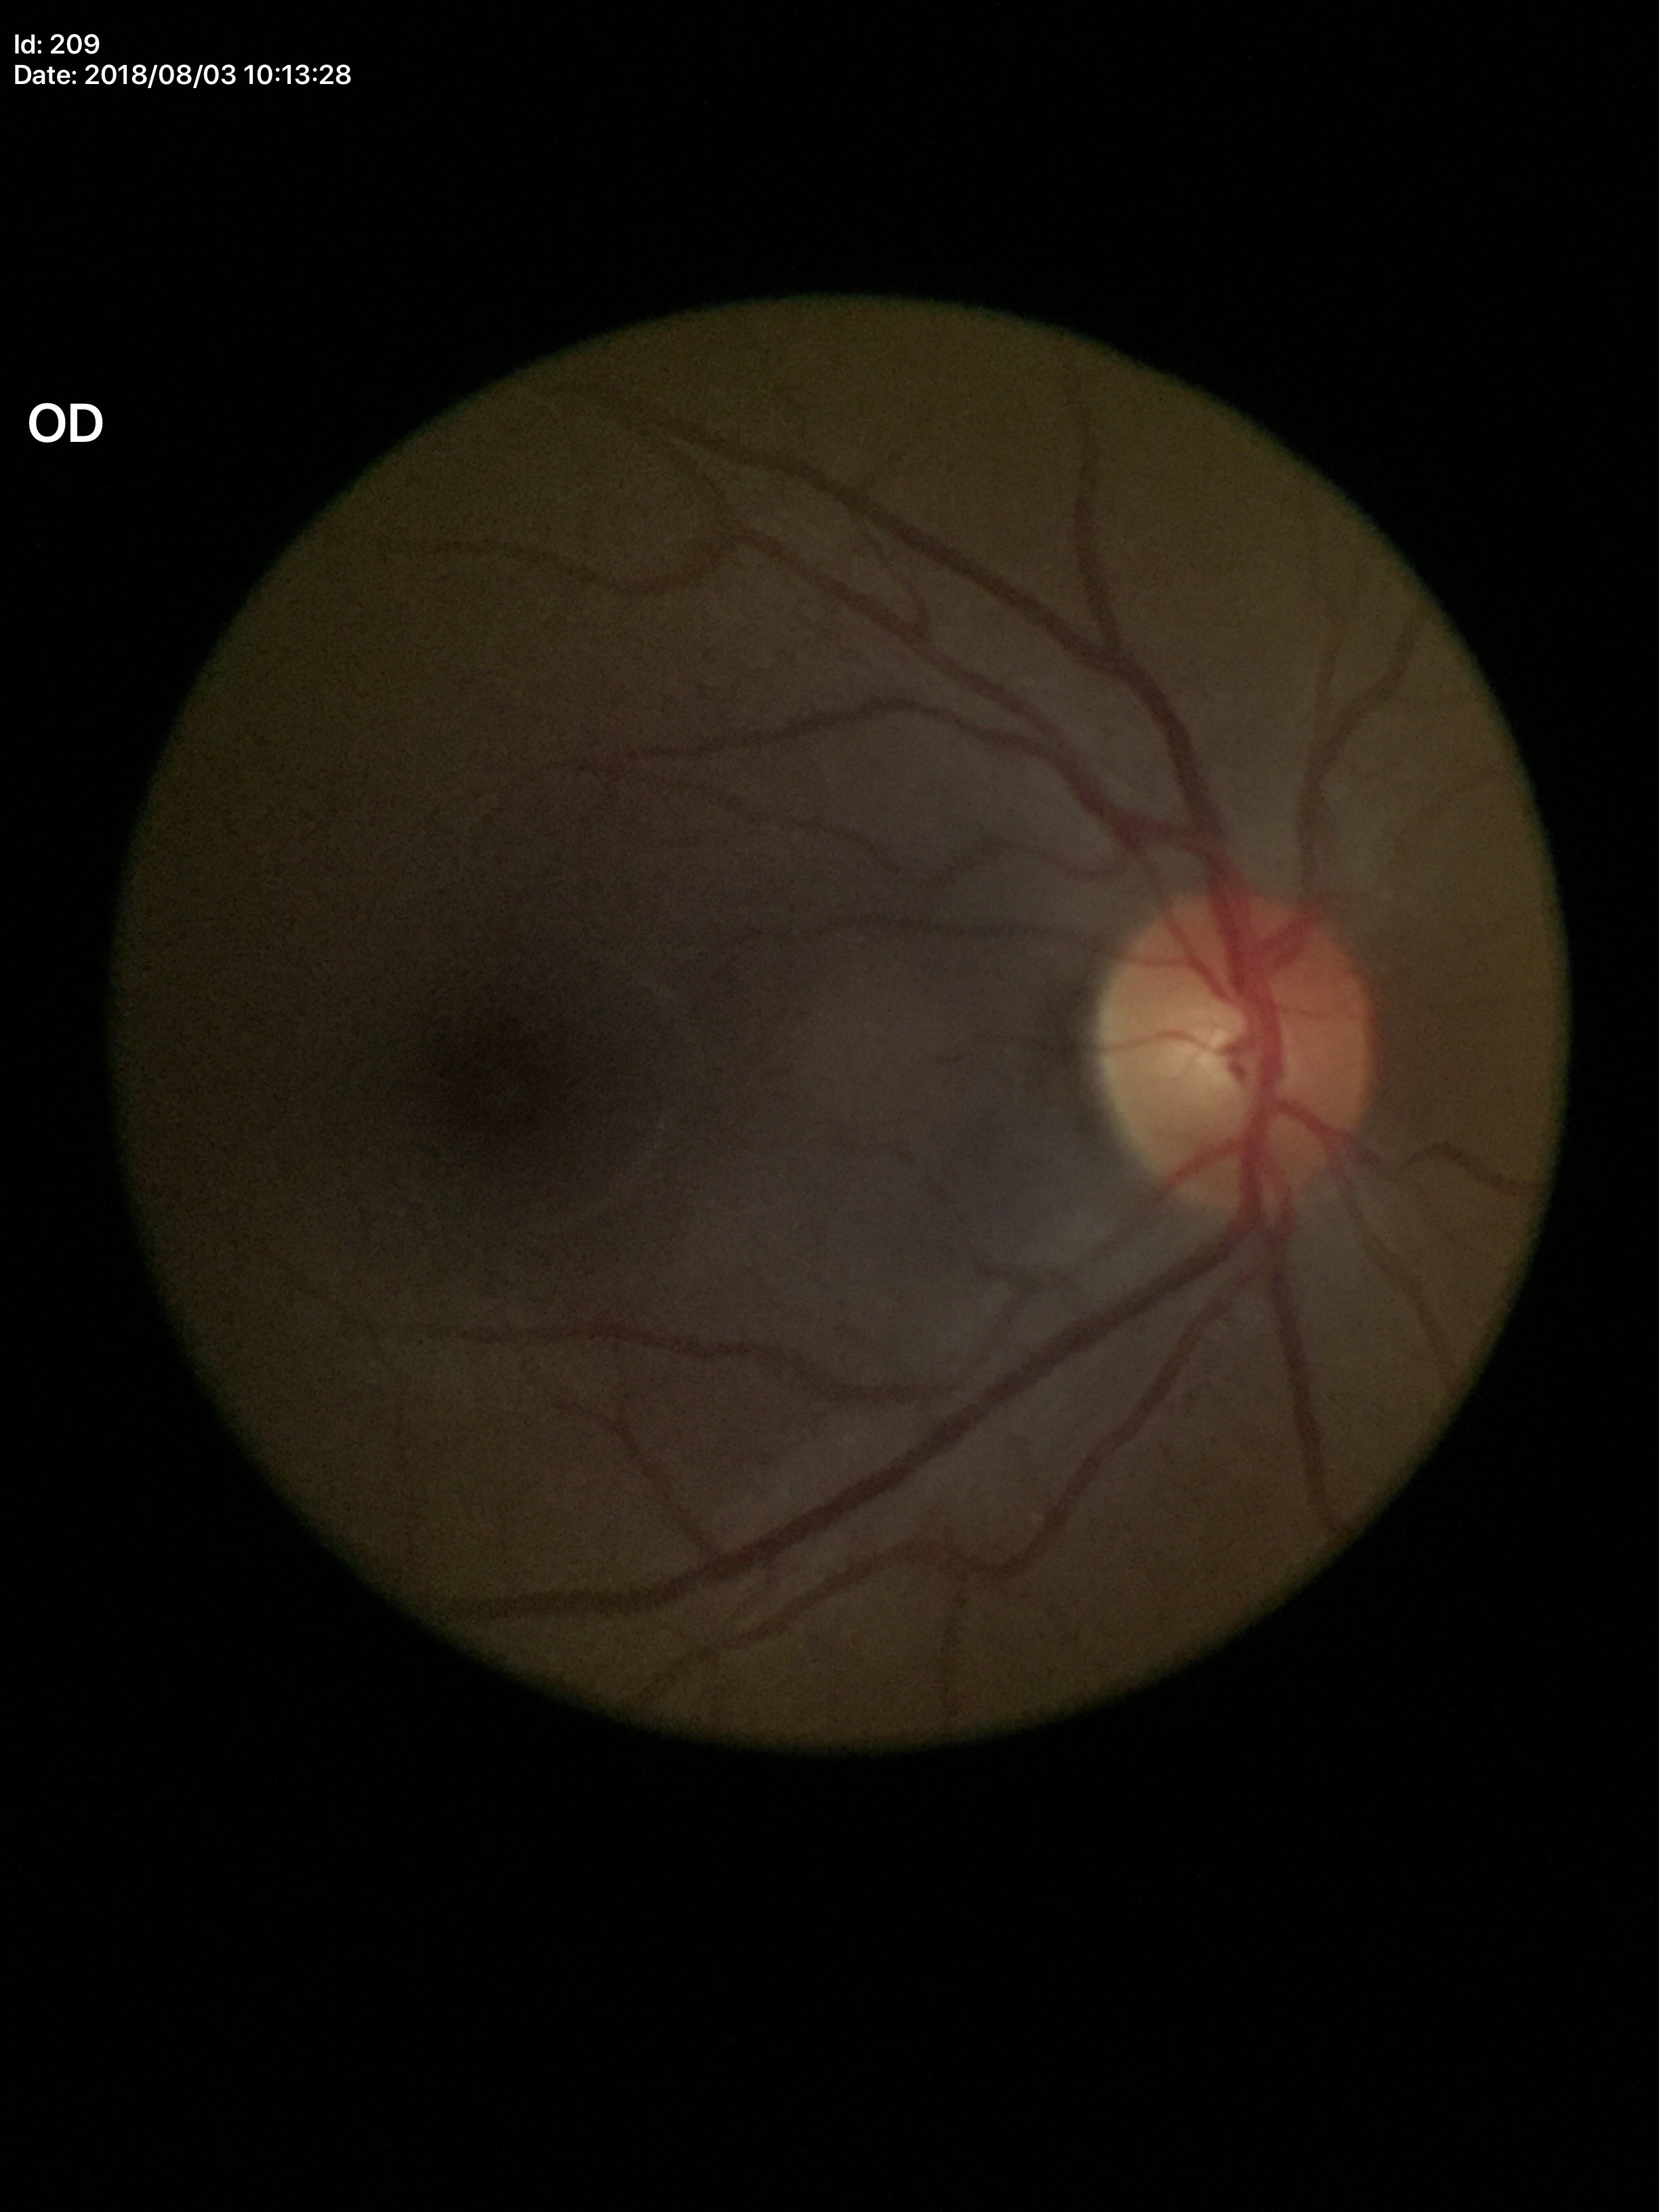

Annotations:
- Glaucoma assessment · not suspect (5/5 ophthalmologists in agreement)
- vertical cup-to-disc ratio (VCDR) · 0.40